1932x1910
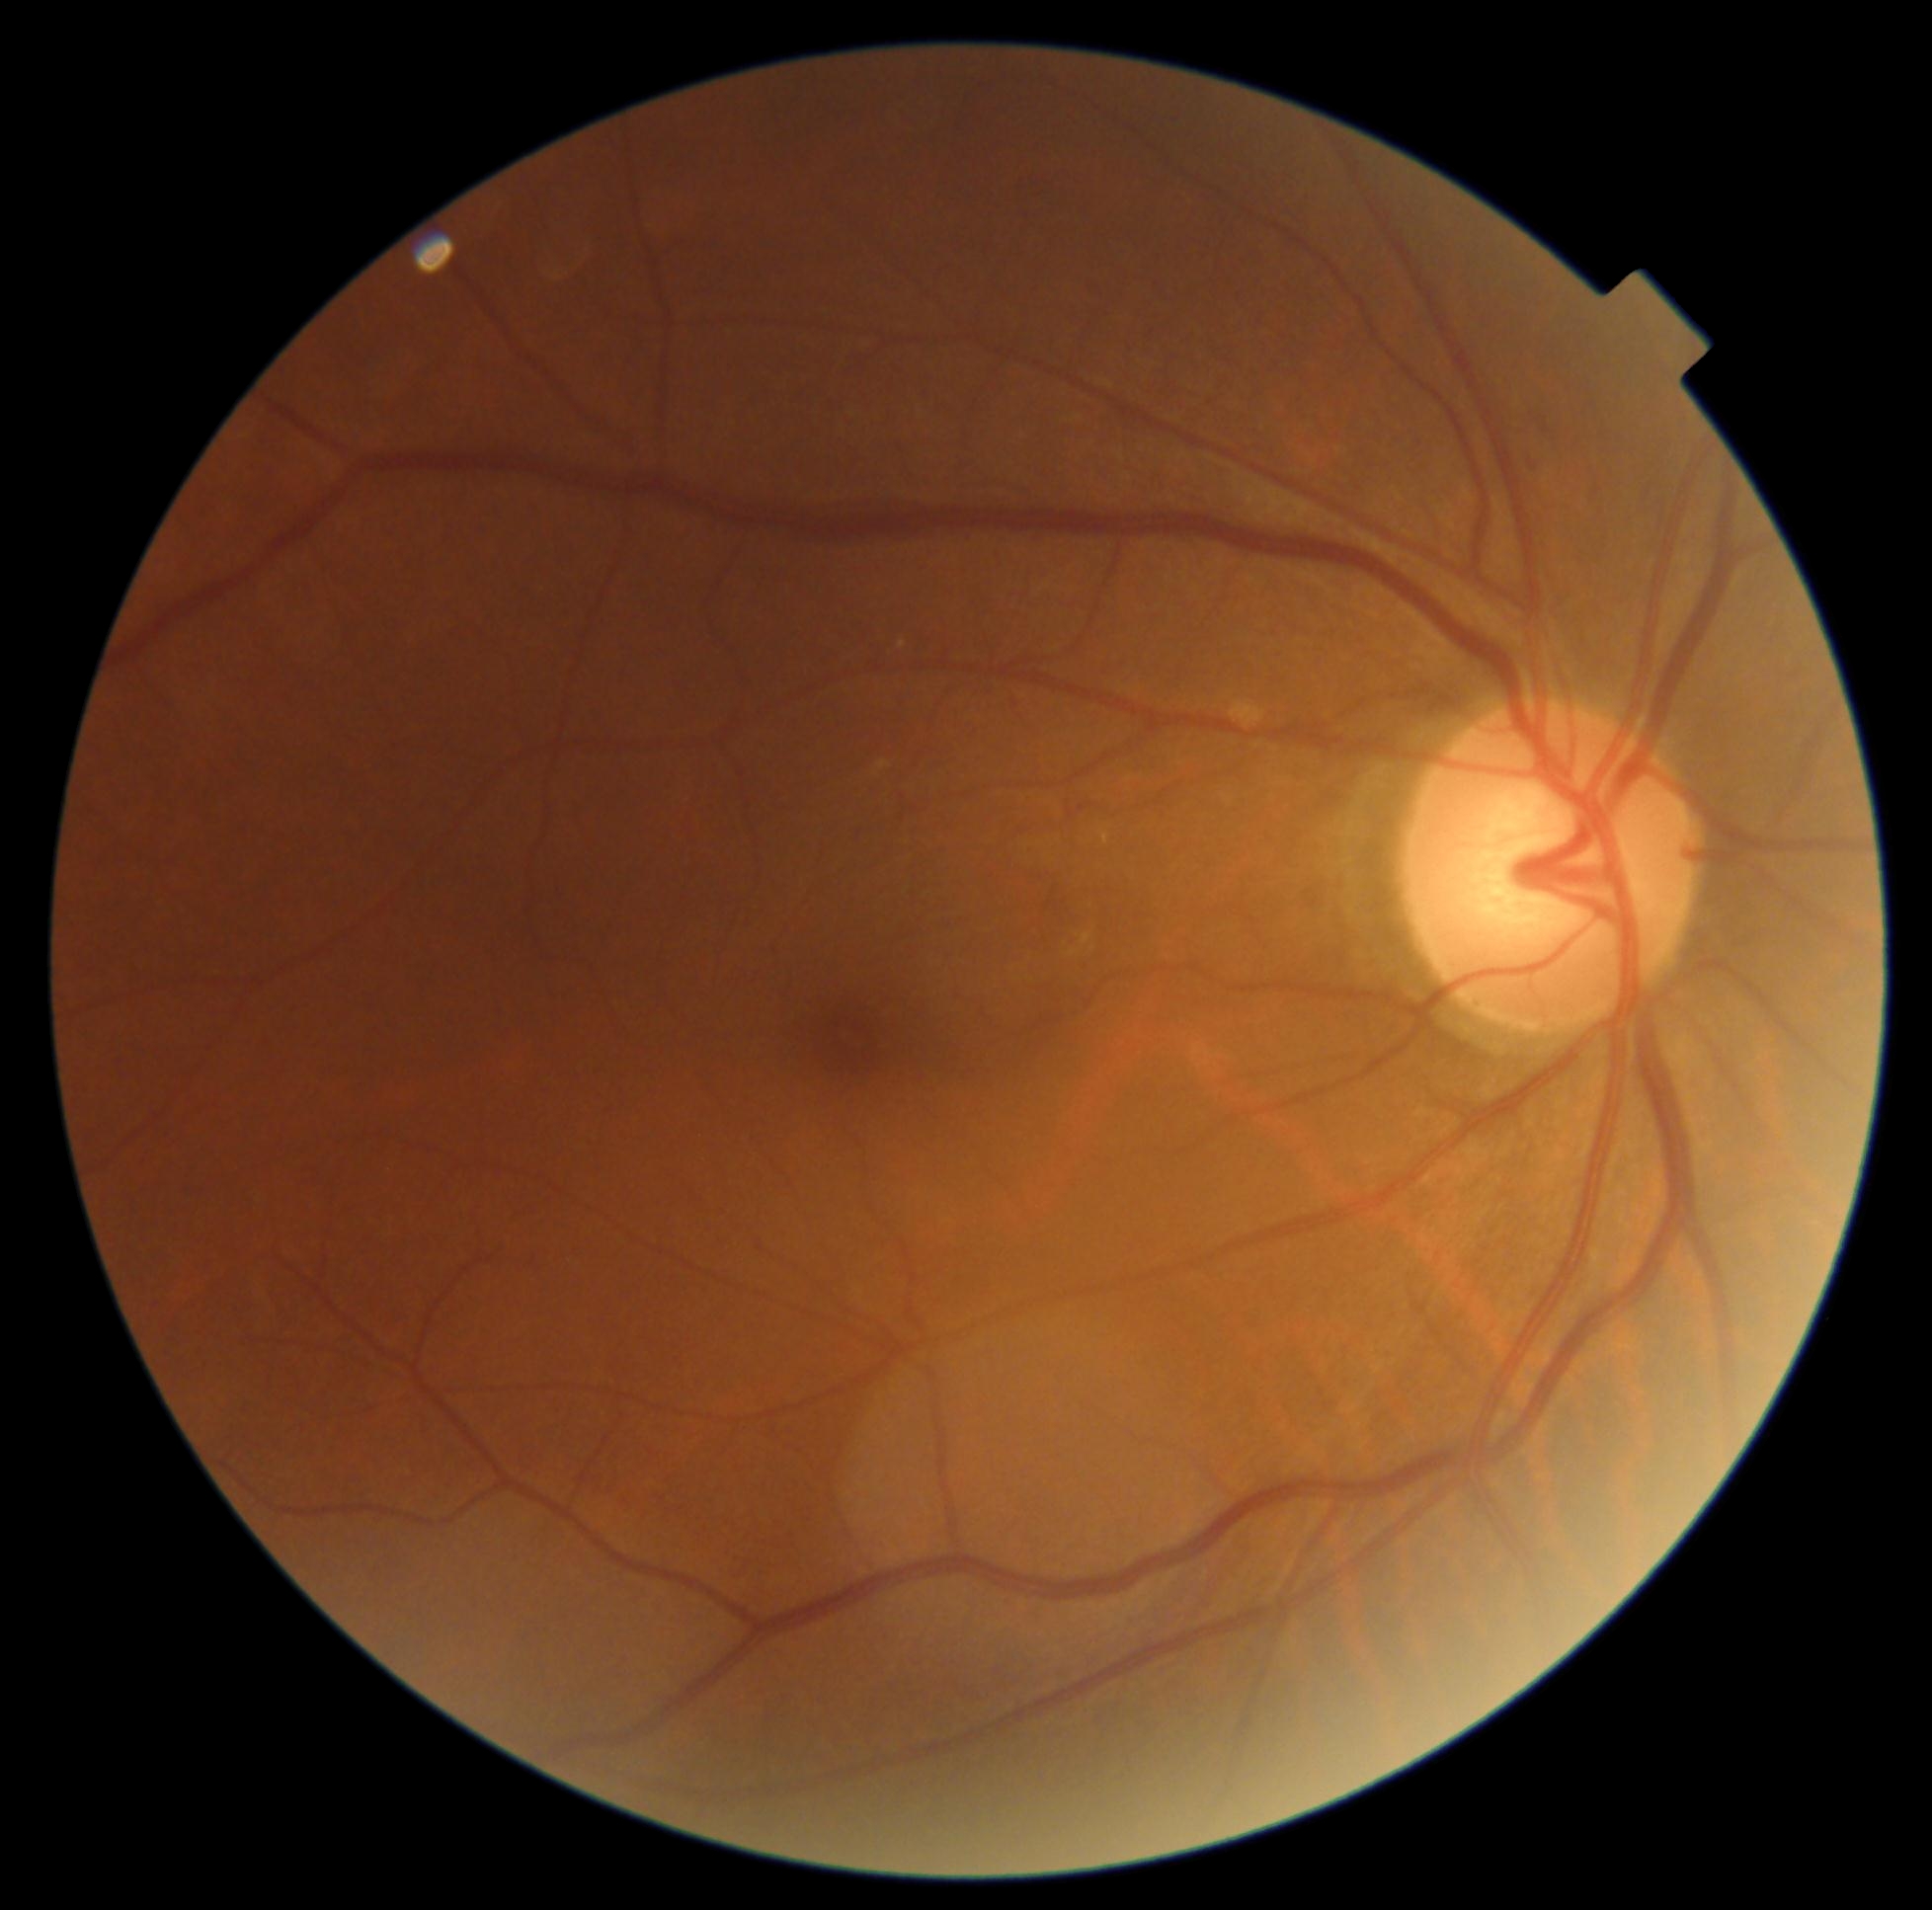 Diabetic retinopathy is 2.